Fundus photo · centered on the macula — 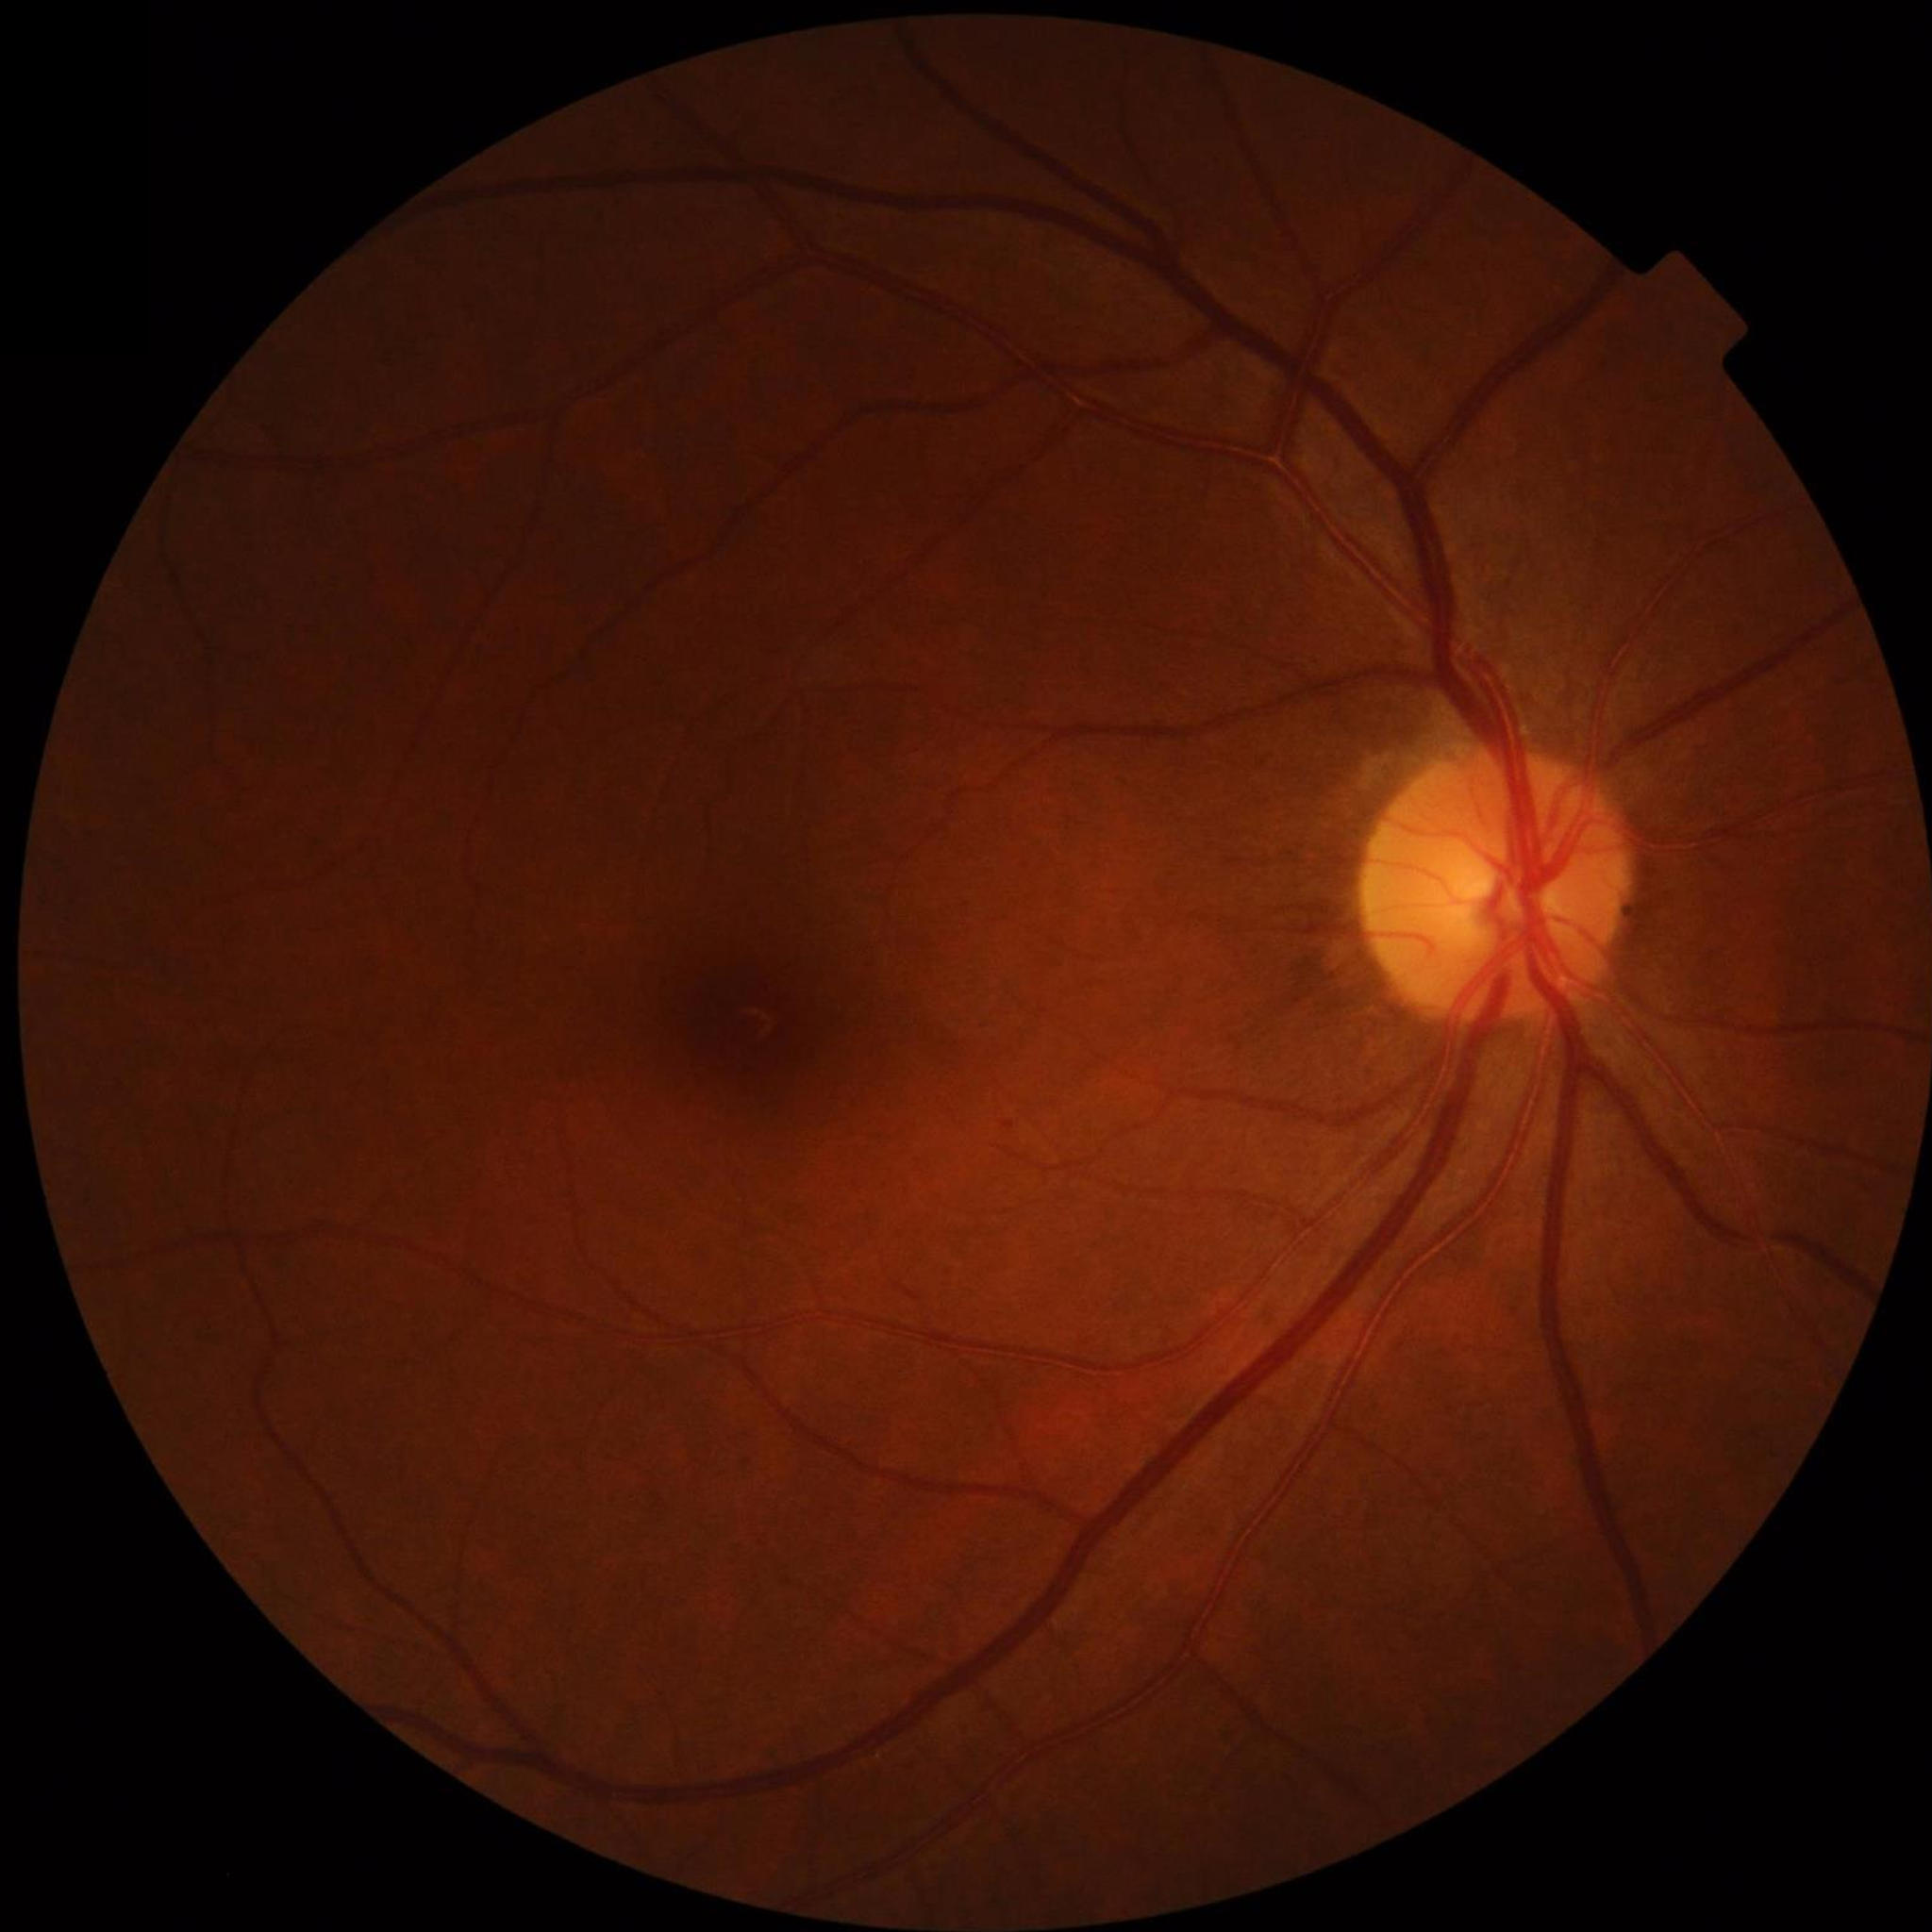 {
  "diagnosis": "no AMD, DR, or glaucomatous findings"
}